Camera: NIDEK AFC-230 · FOV: 45 degrees · posterior pole photograph:
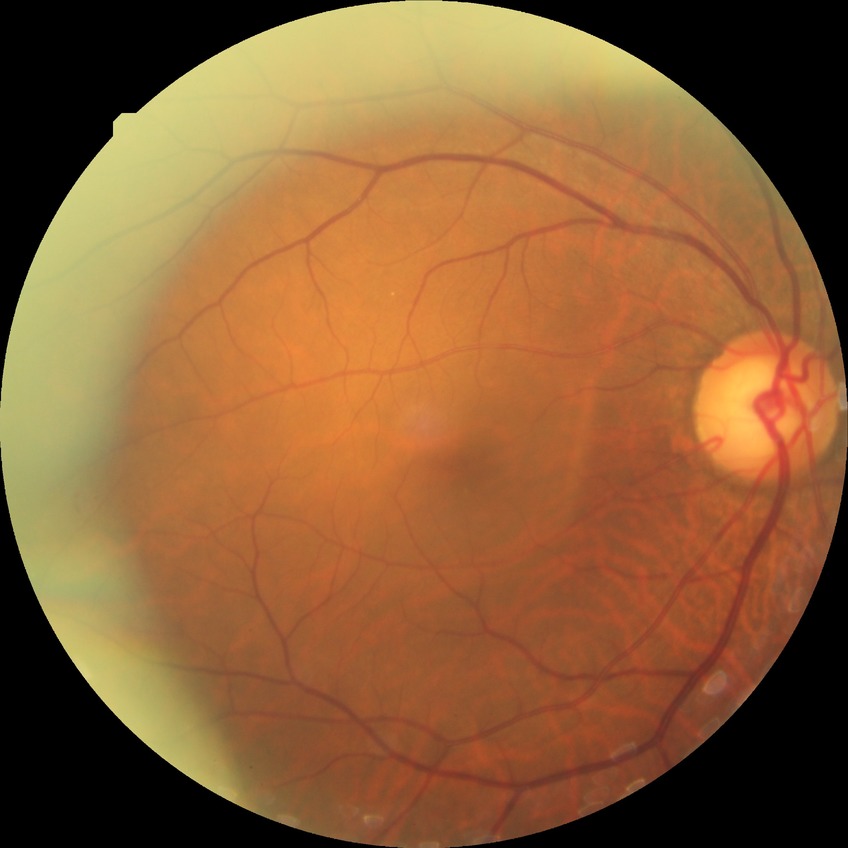
Diabetic retinopathy (DR) is NDR (no diabetic retinopathy).